Pediatric wide-field fundus photograph; image size 640x480: 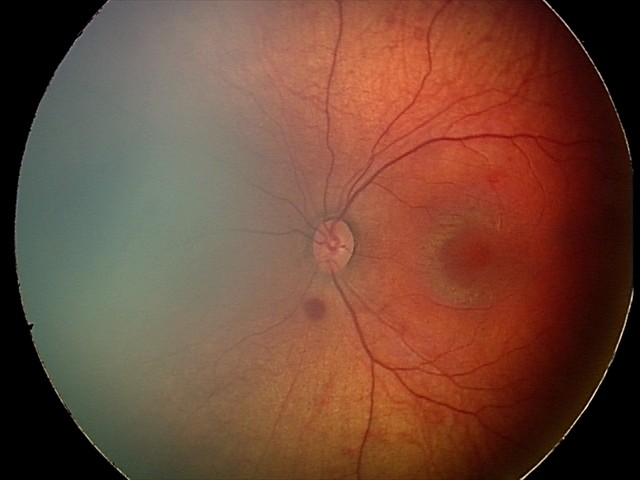
Examination diagnosed as retinal hemorrhages.